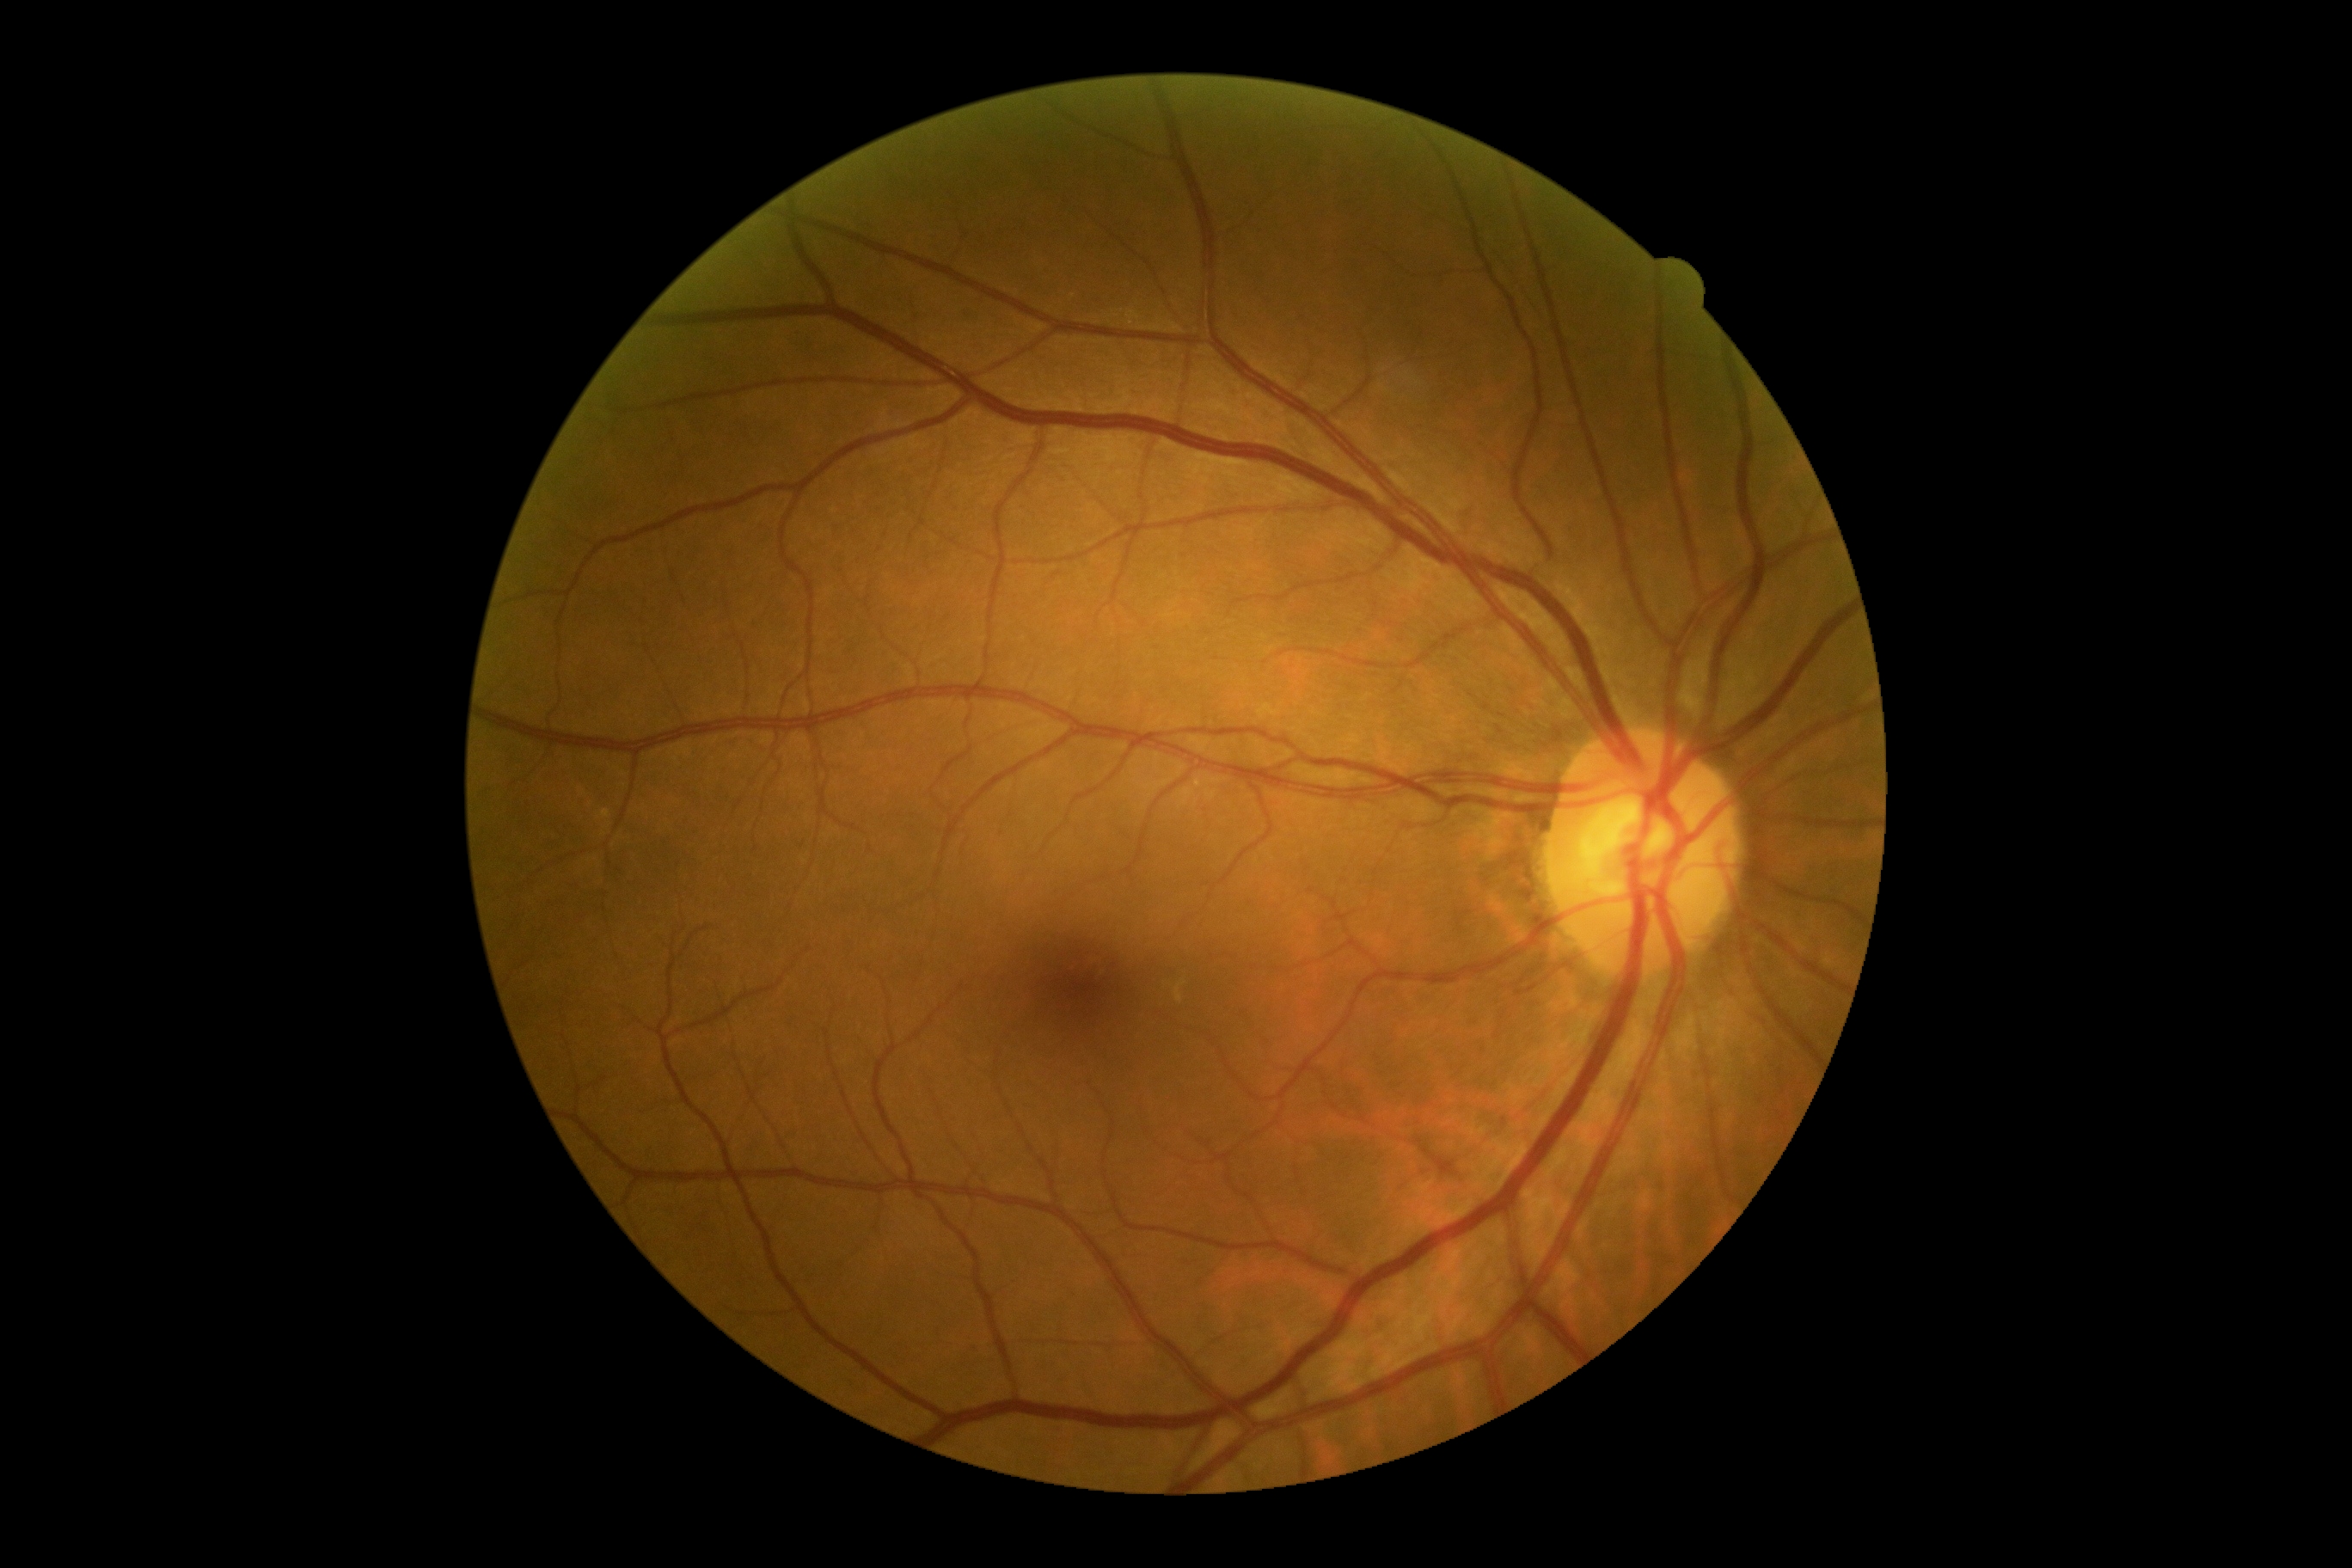
DR grade: 0 (no apparent retinopathy). No diabetic retinal disease findings.